Pediatric retinal photograph (wide-field); 130° field of view (Clarity RetCam 3).
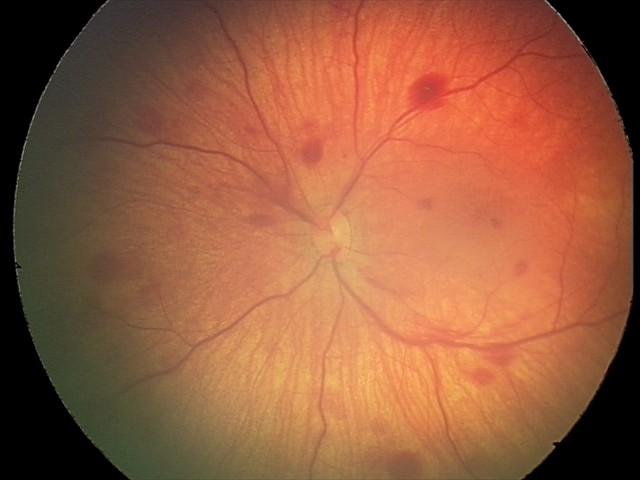 Screening series with retinal hemorrhages.